NIDEK AFC-230 fundus camera: 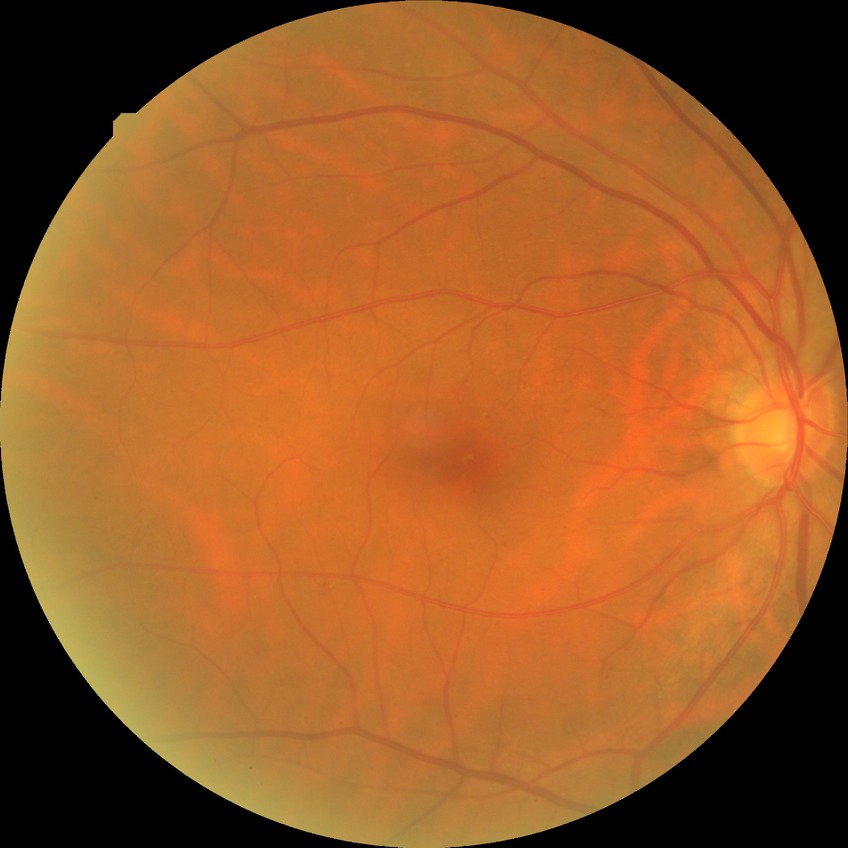 Diabetic retinopathy stage: simple diabetic retinopathy.